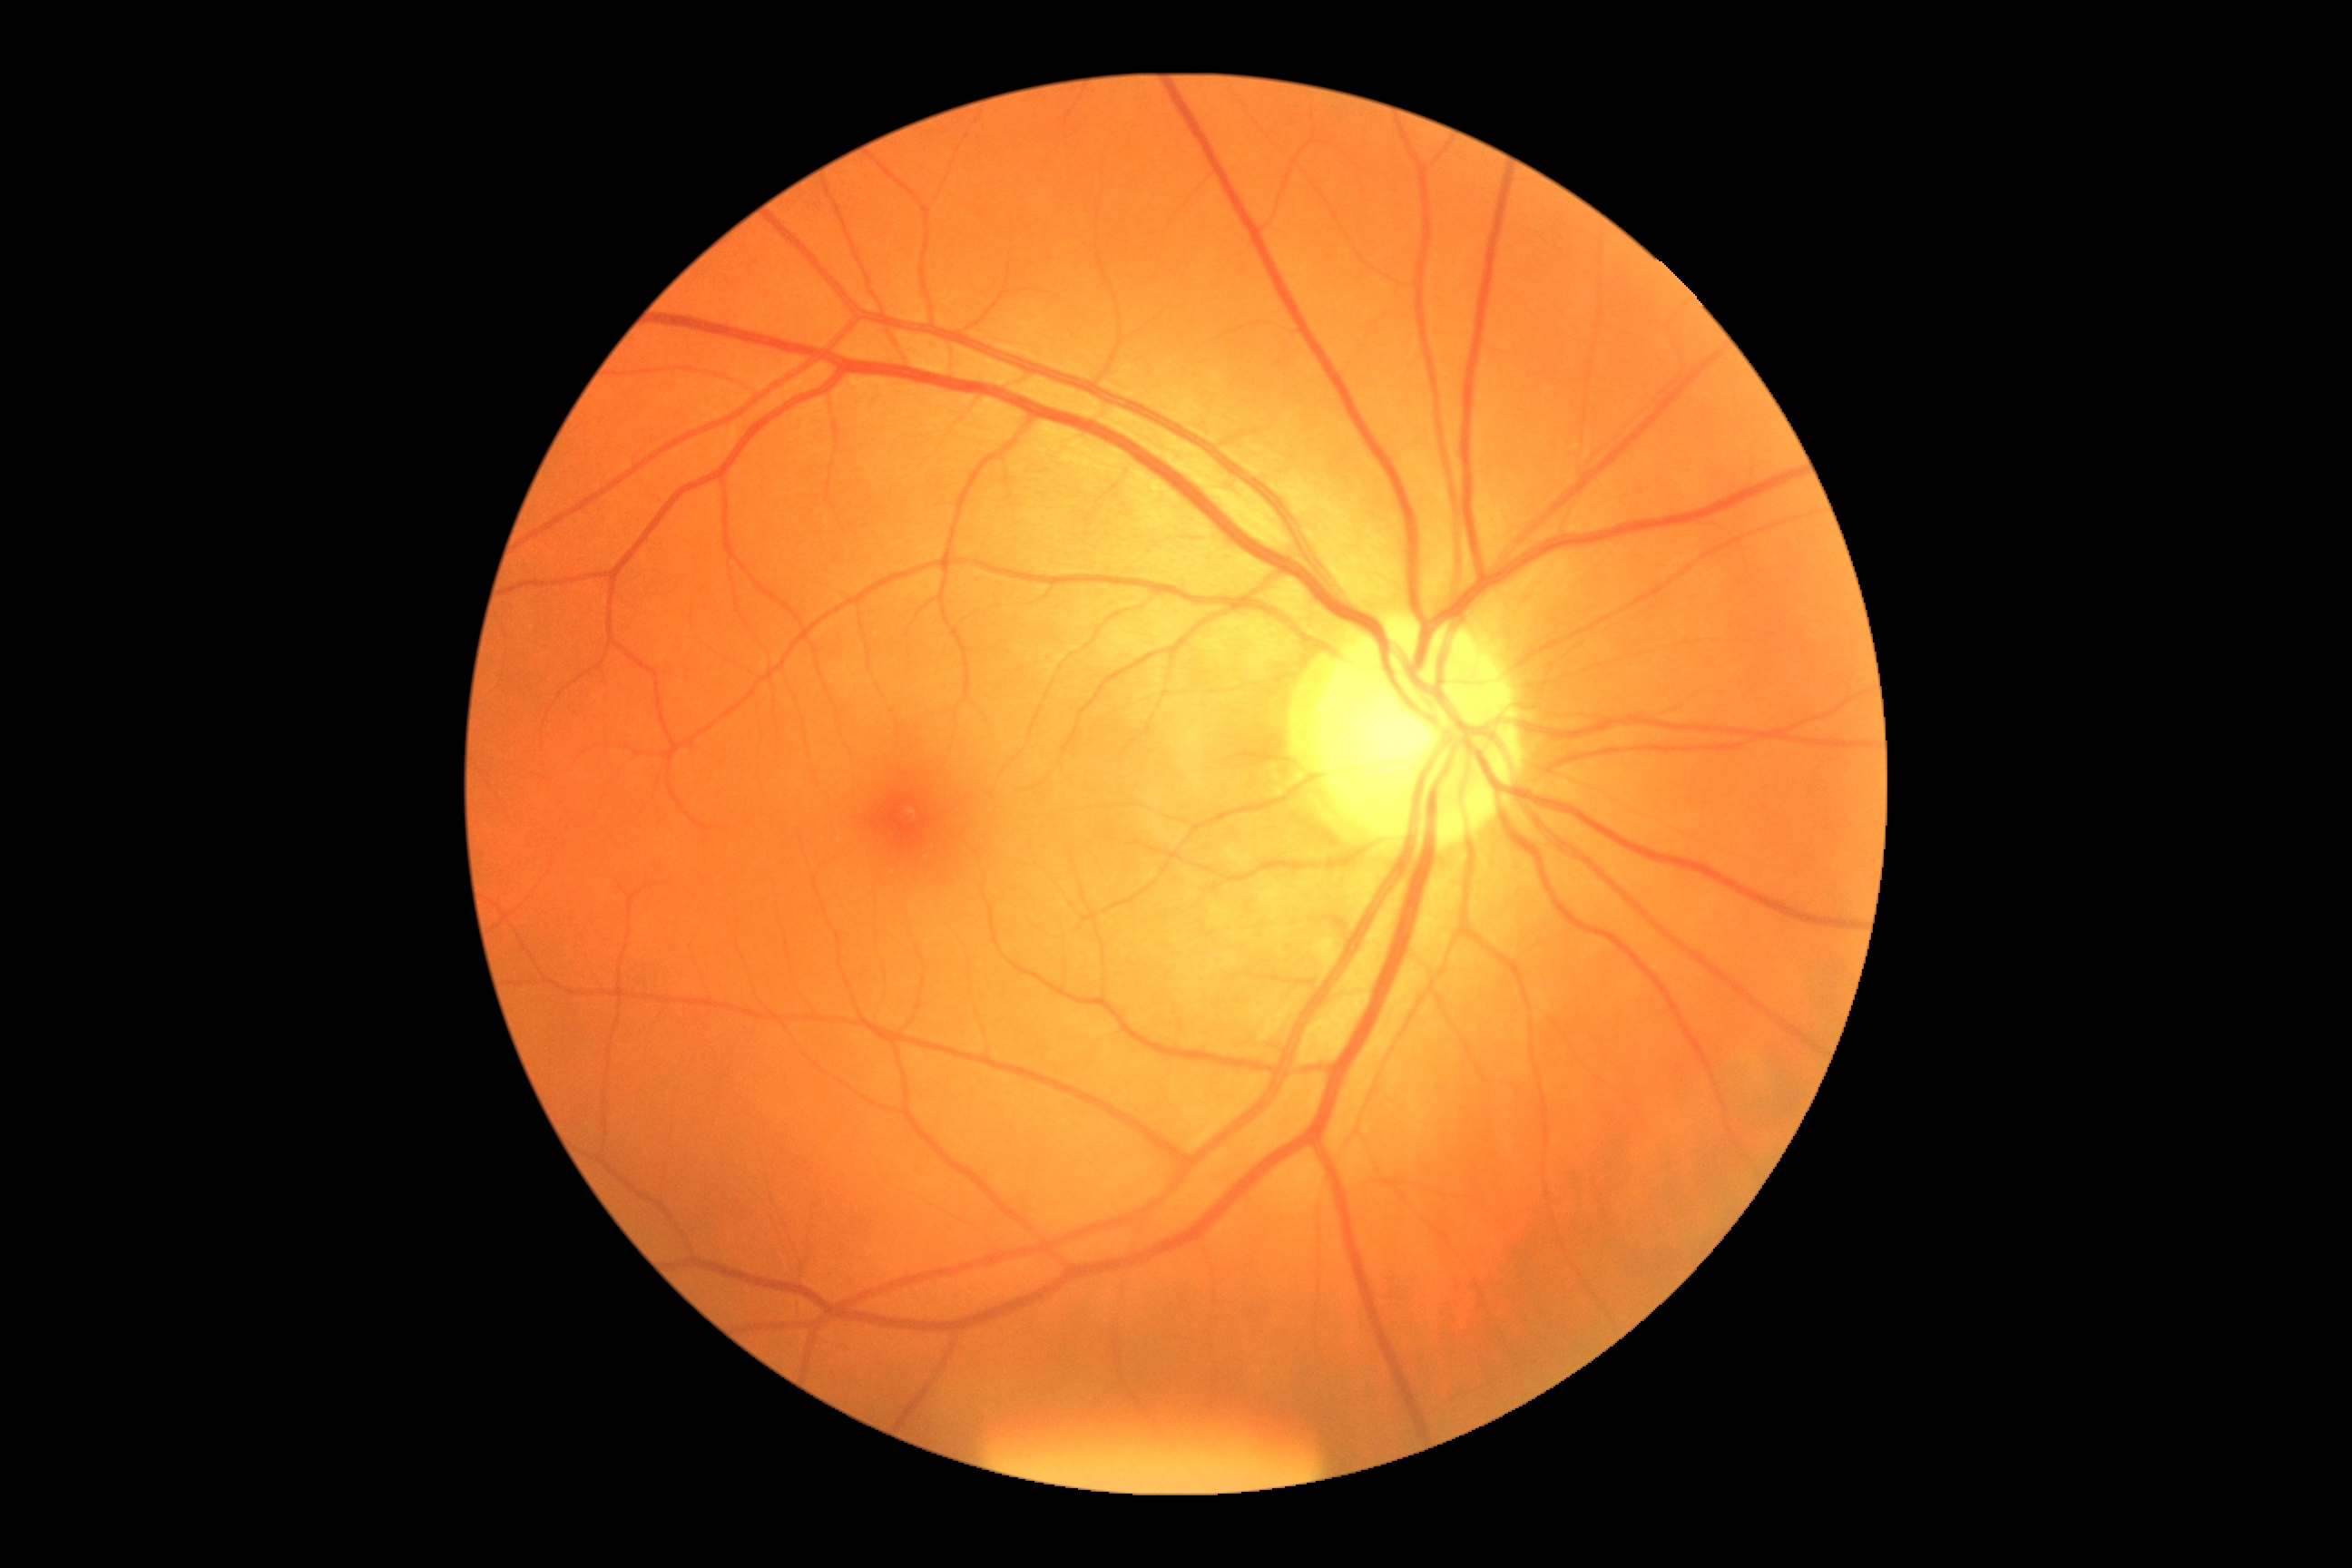
Retinopathy grade: 0 (no apparent retinopathy). No apparent diabetic retinopathy.